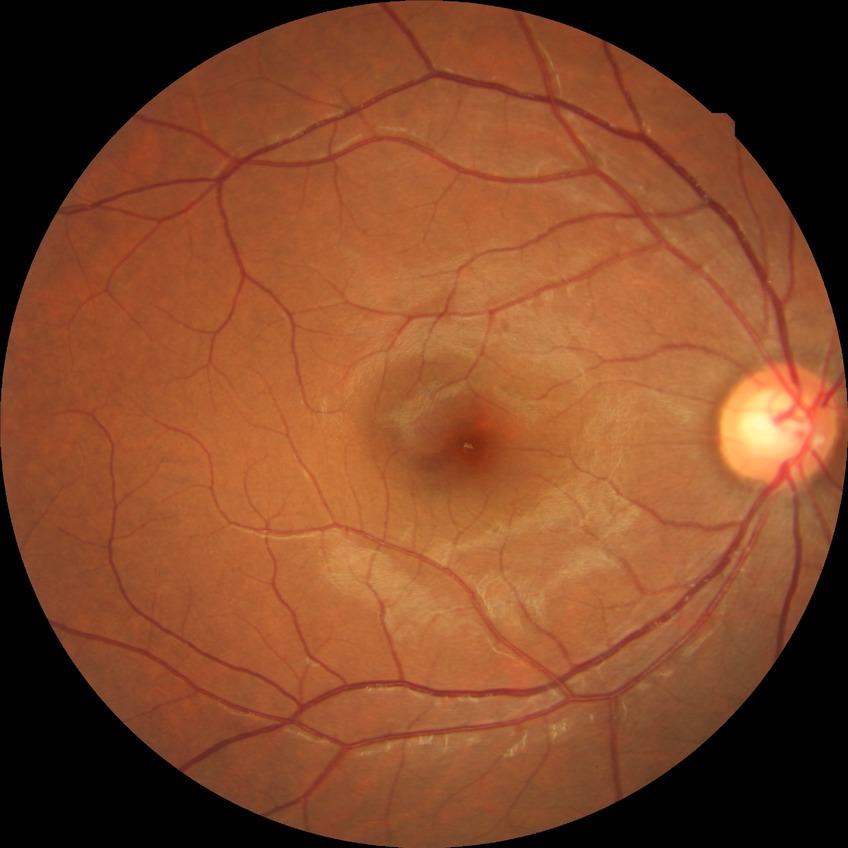 Retinopathy grade: no diabetic retinopathy.